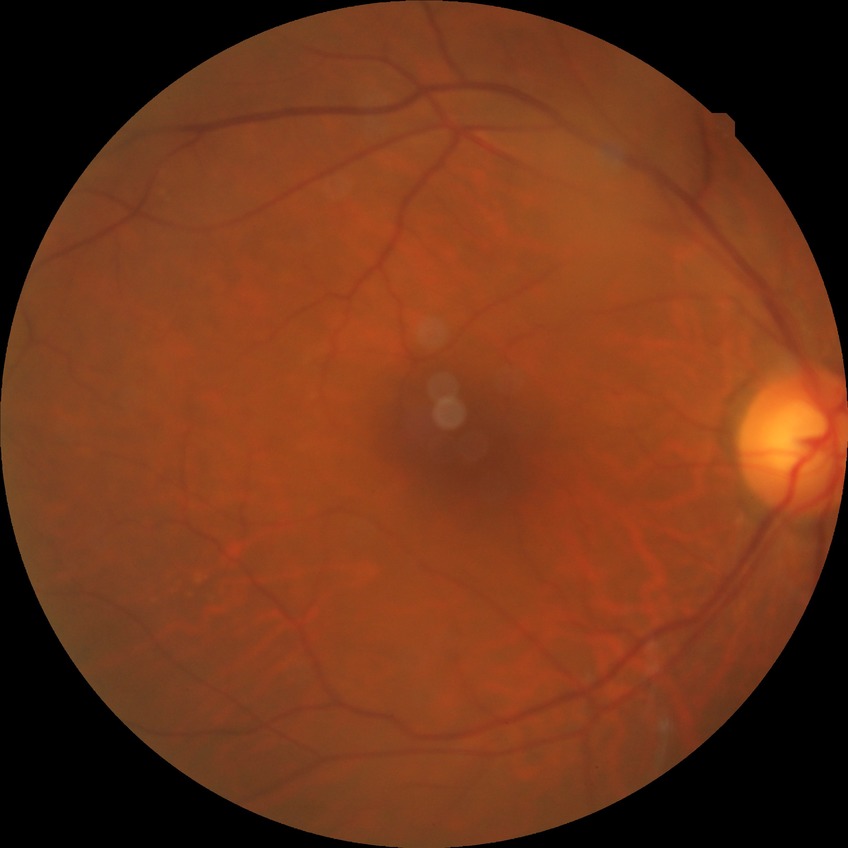

DR stage = NDR.